2048 x 1536 pixels, 45-degree field of view:
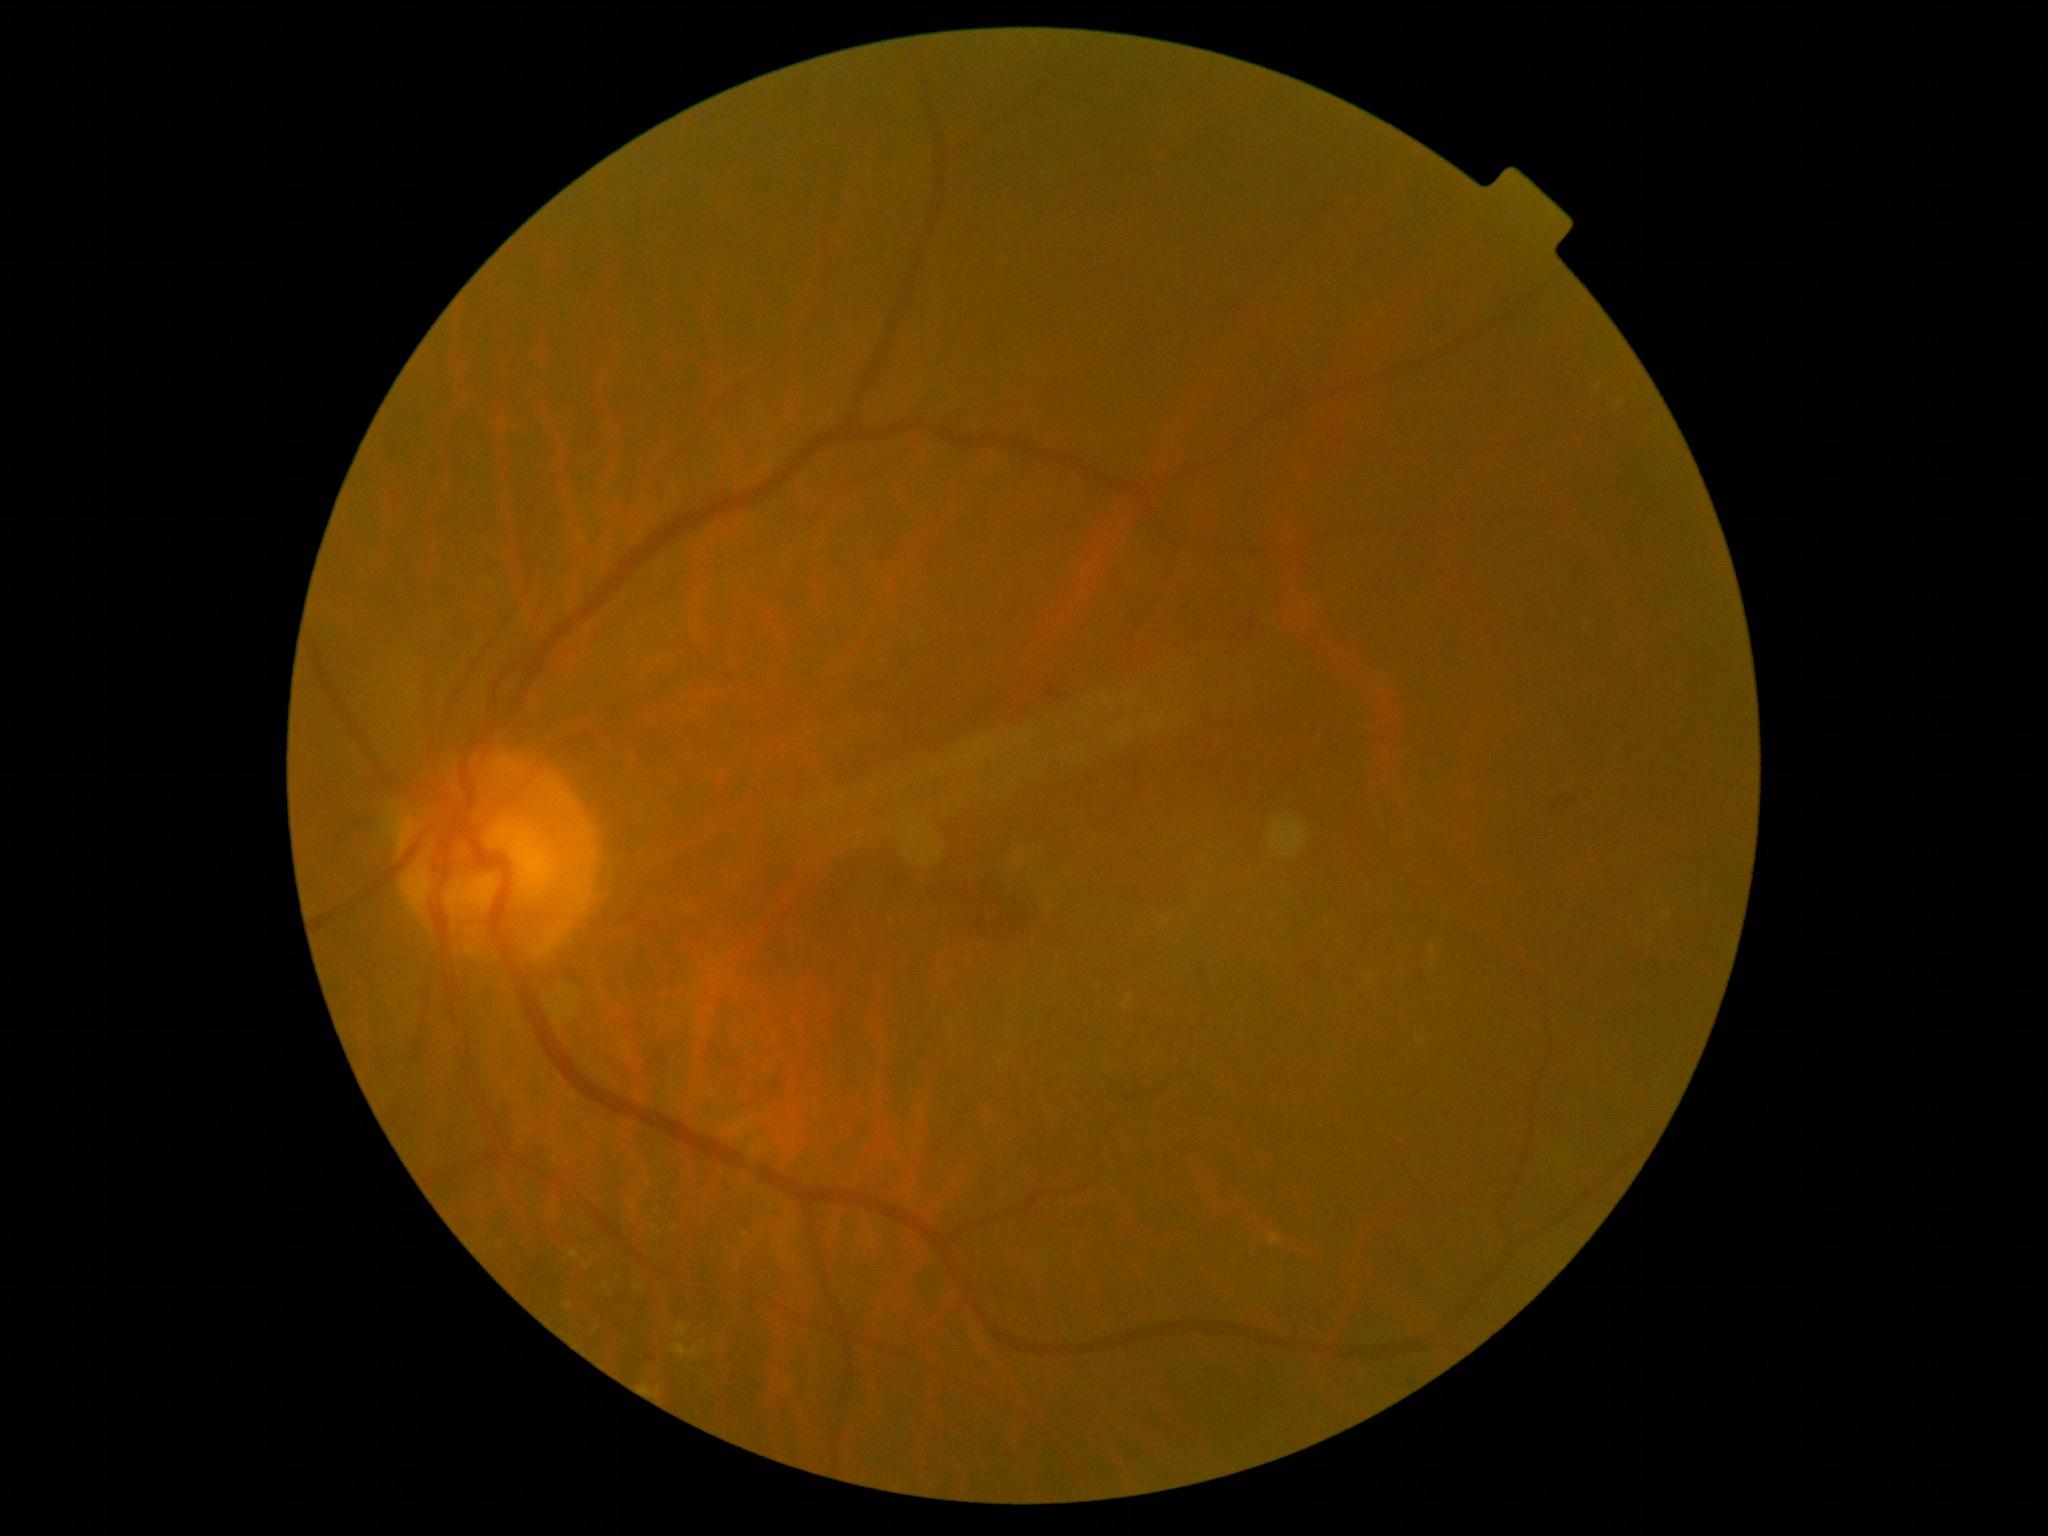

Diabetic retinopathy (DR): grade 2.